Camera: NIDEK AFC-230 — 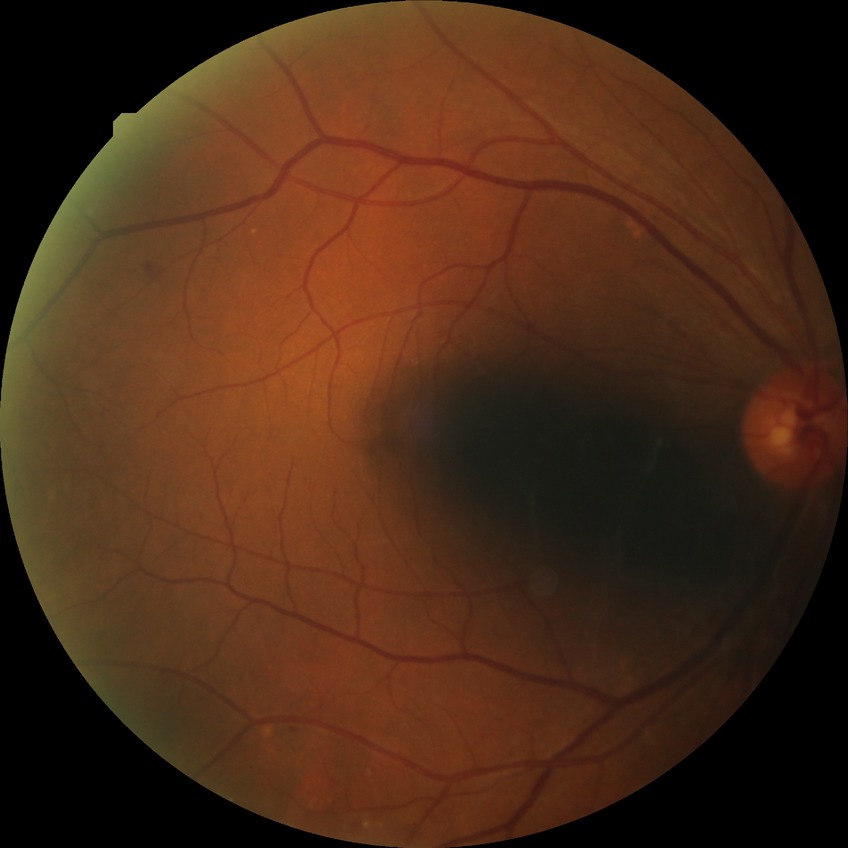 • diabetic retinopathy (DR) — NDR (no diabetic retinopathy)